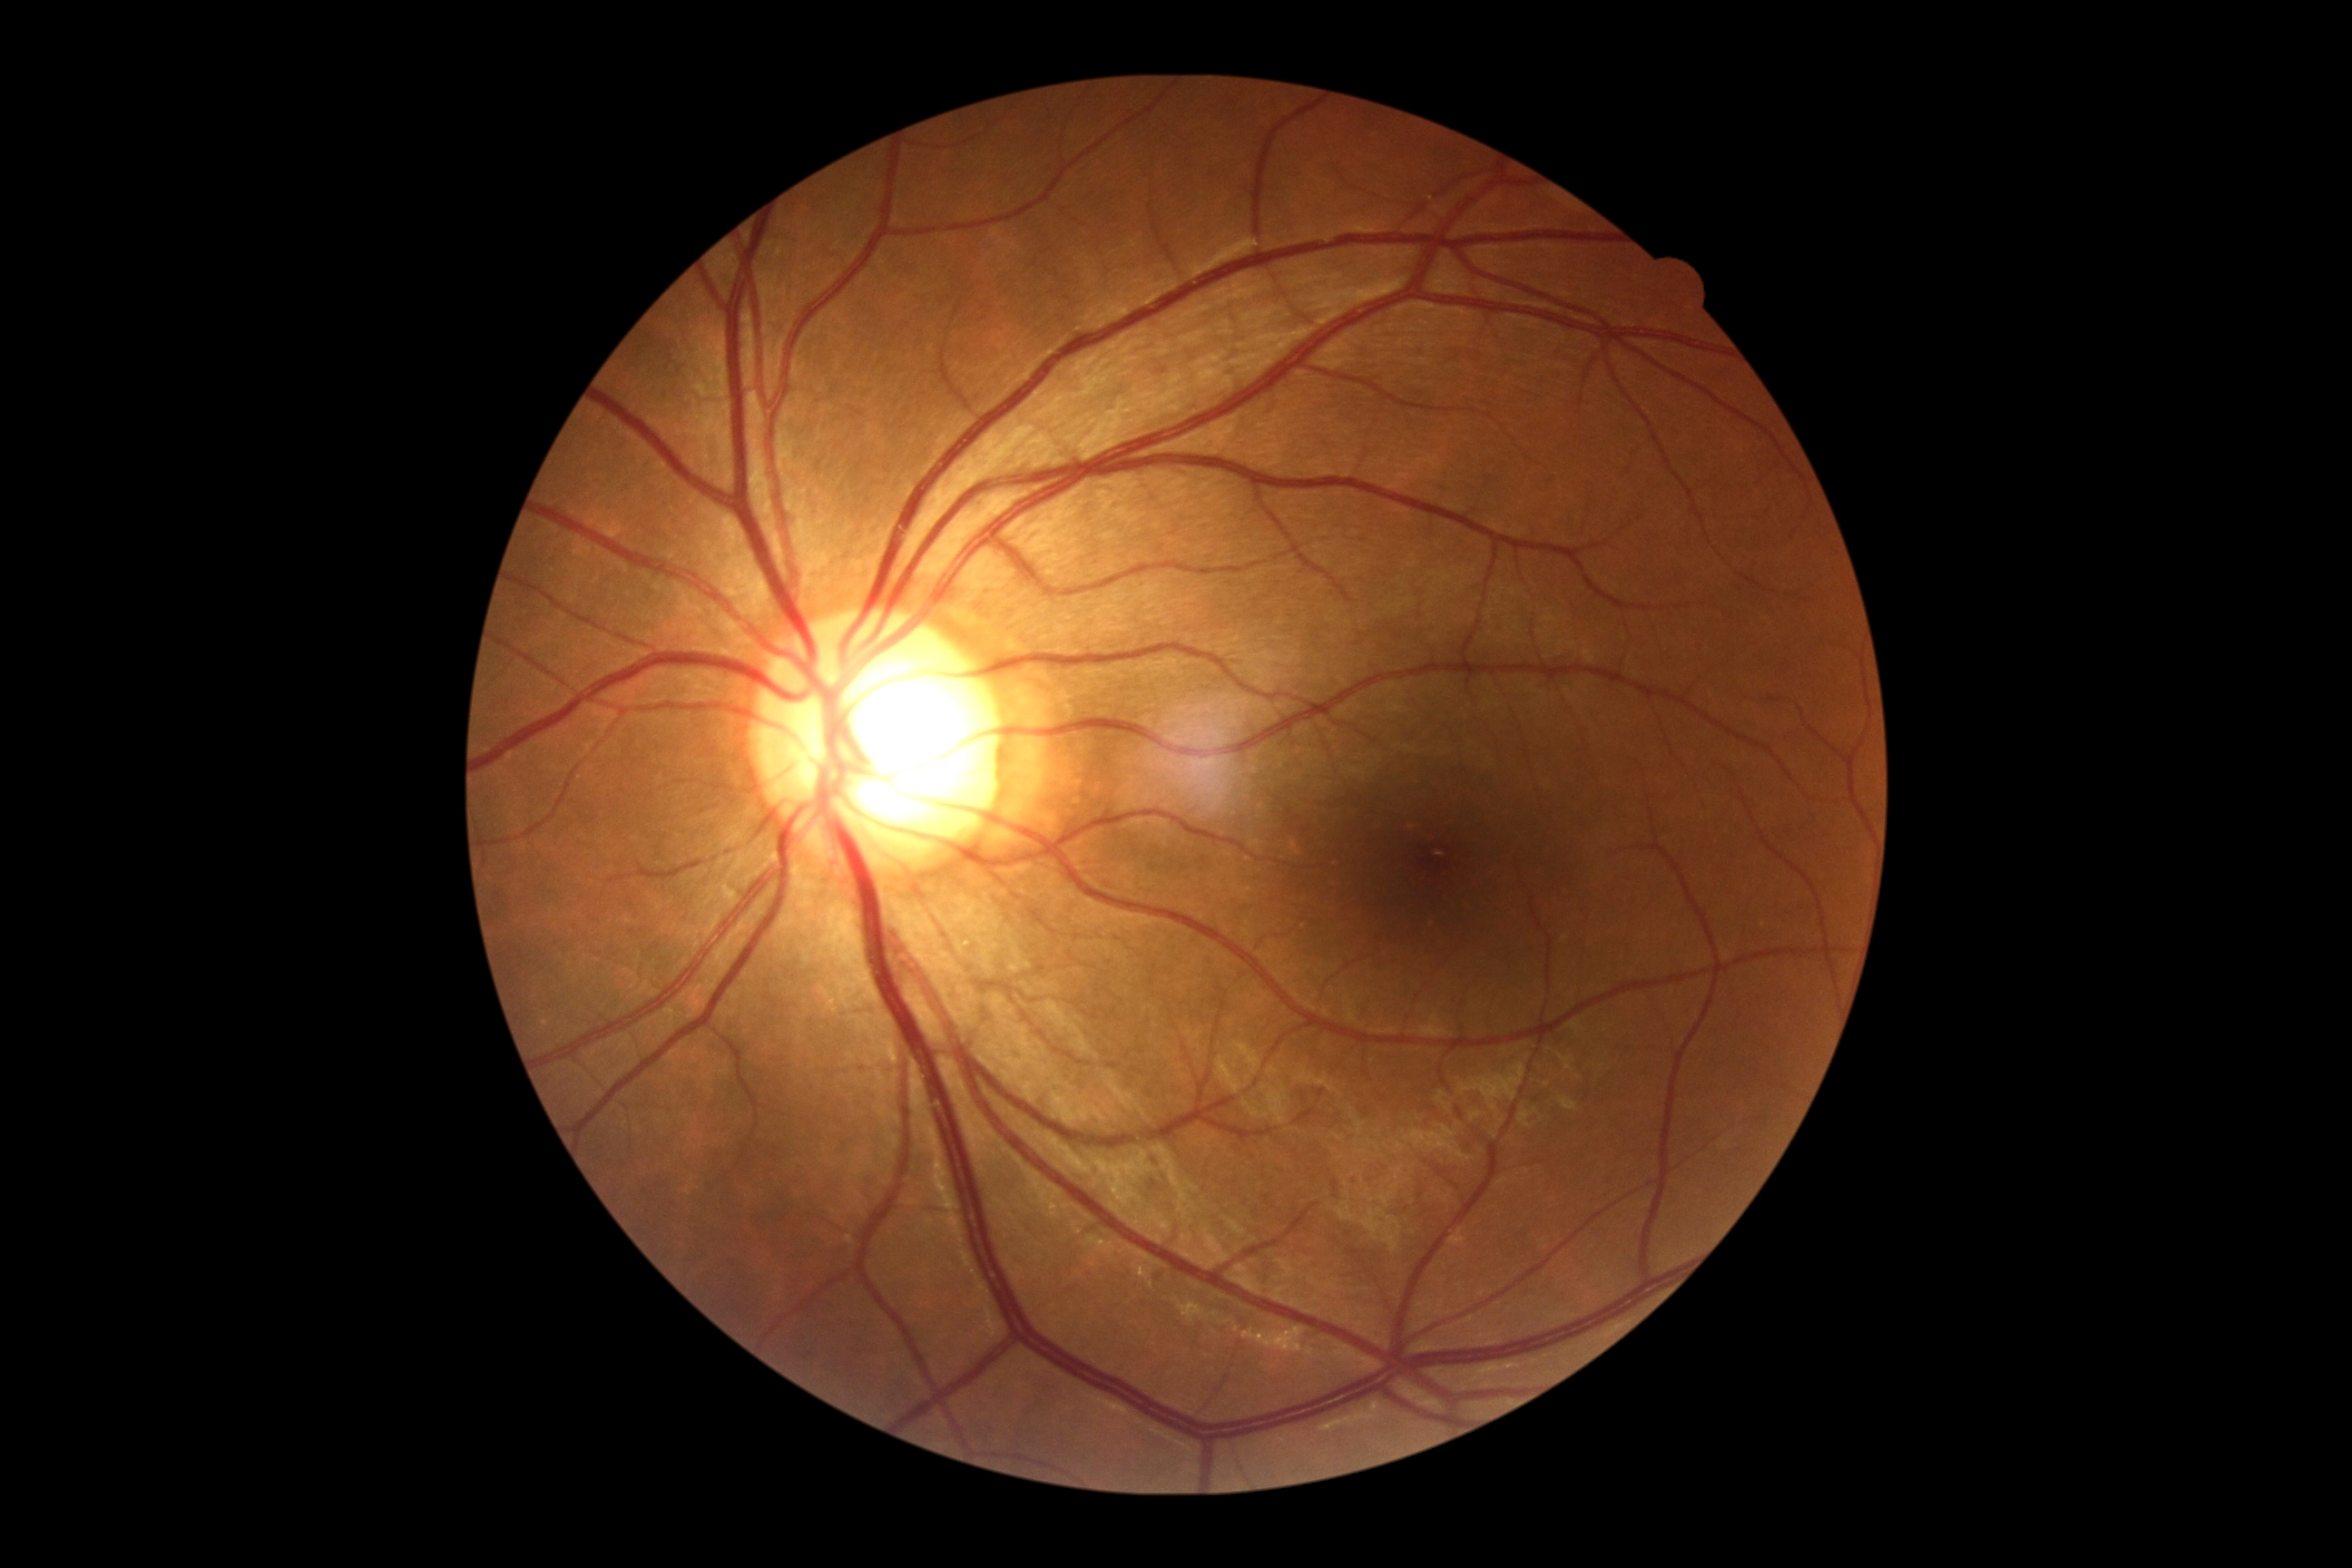
DR = no apparent retinopathy (grade 0).